No pharmacologic dilation.
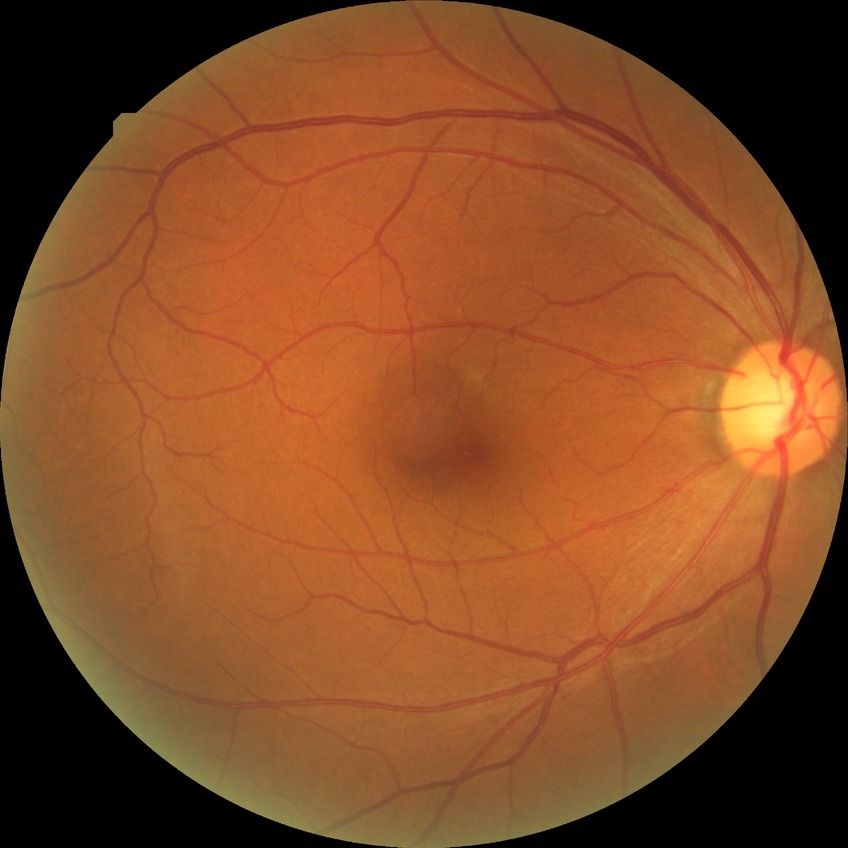
Diabetic retinopathy (DR): NDR (no diabetic retinopathy).